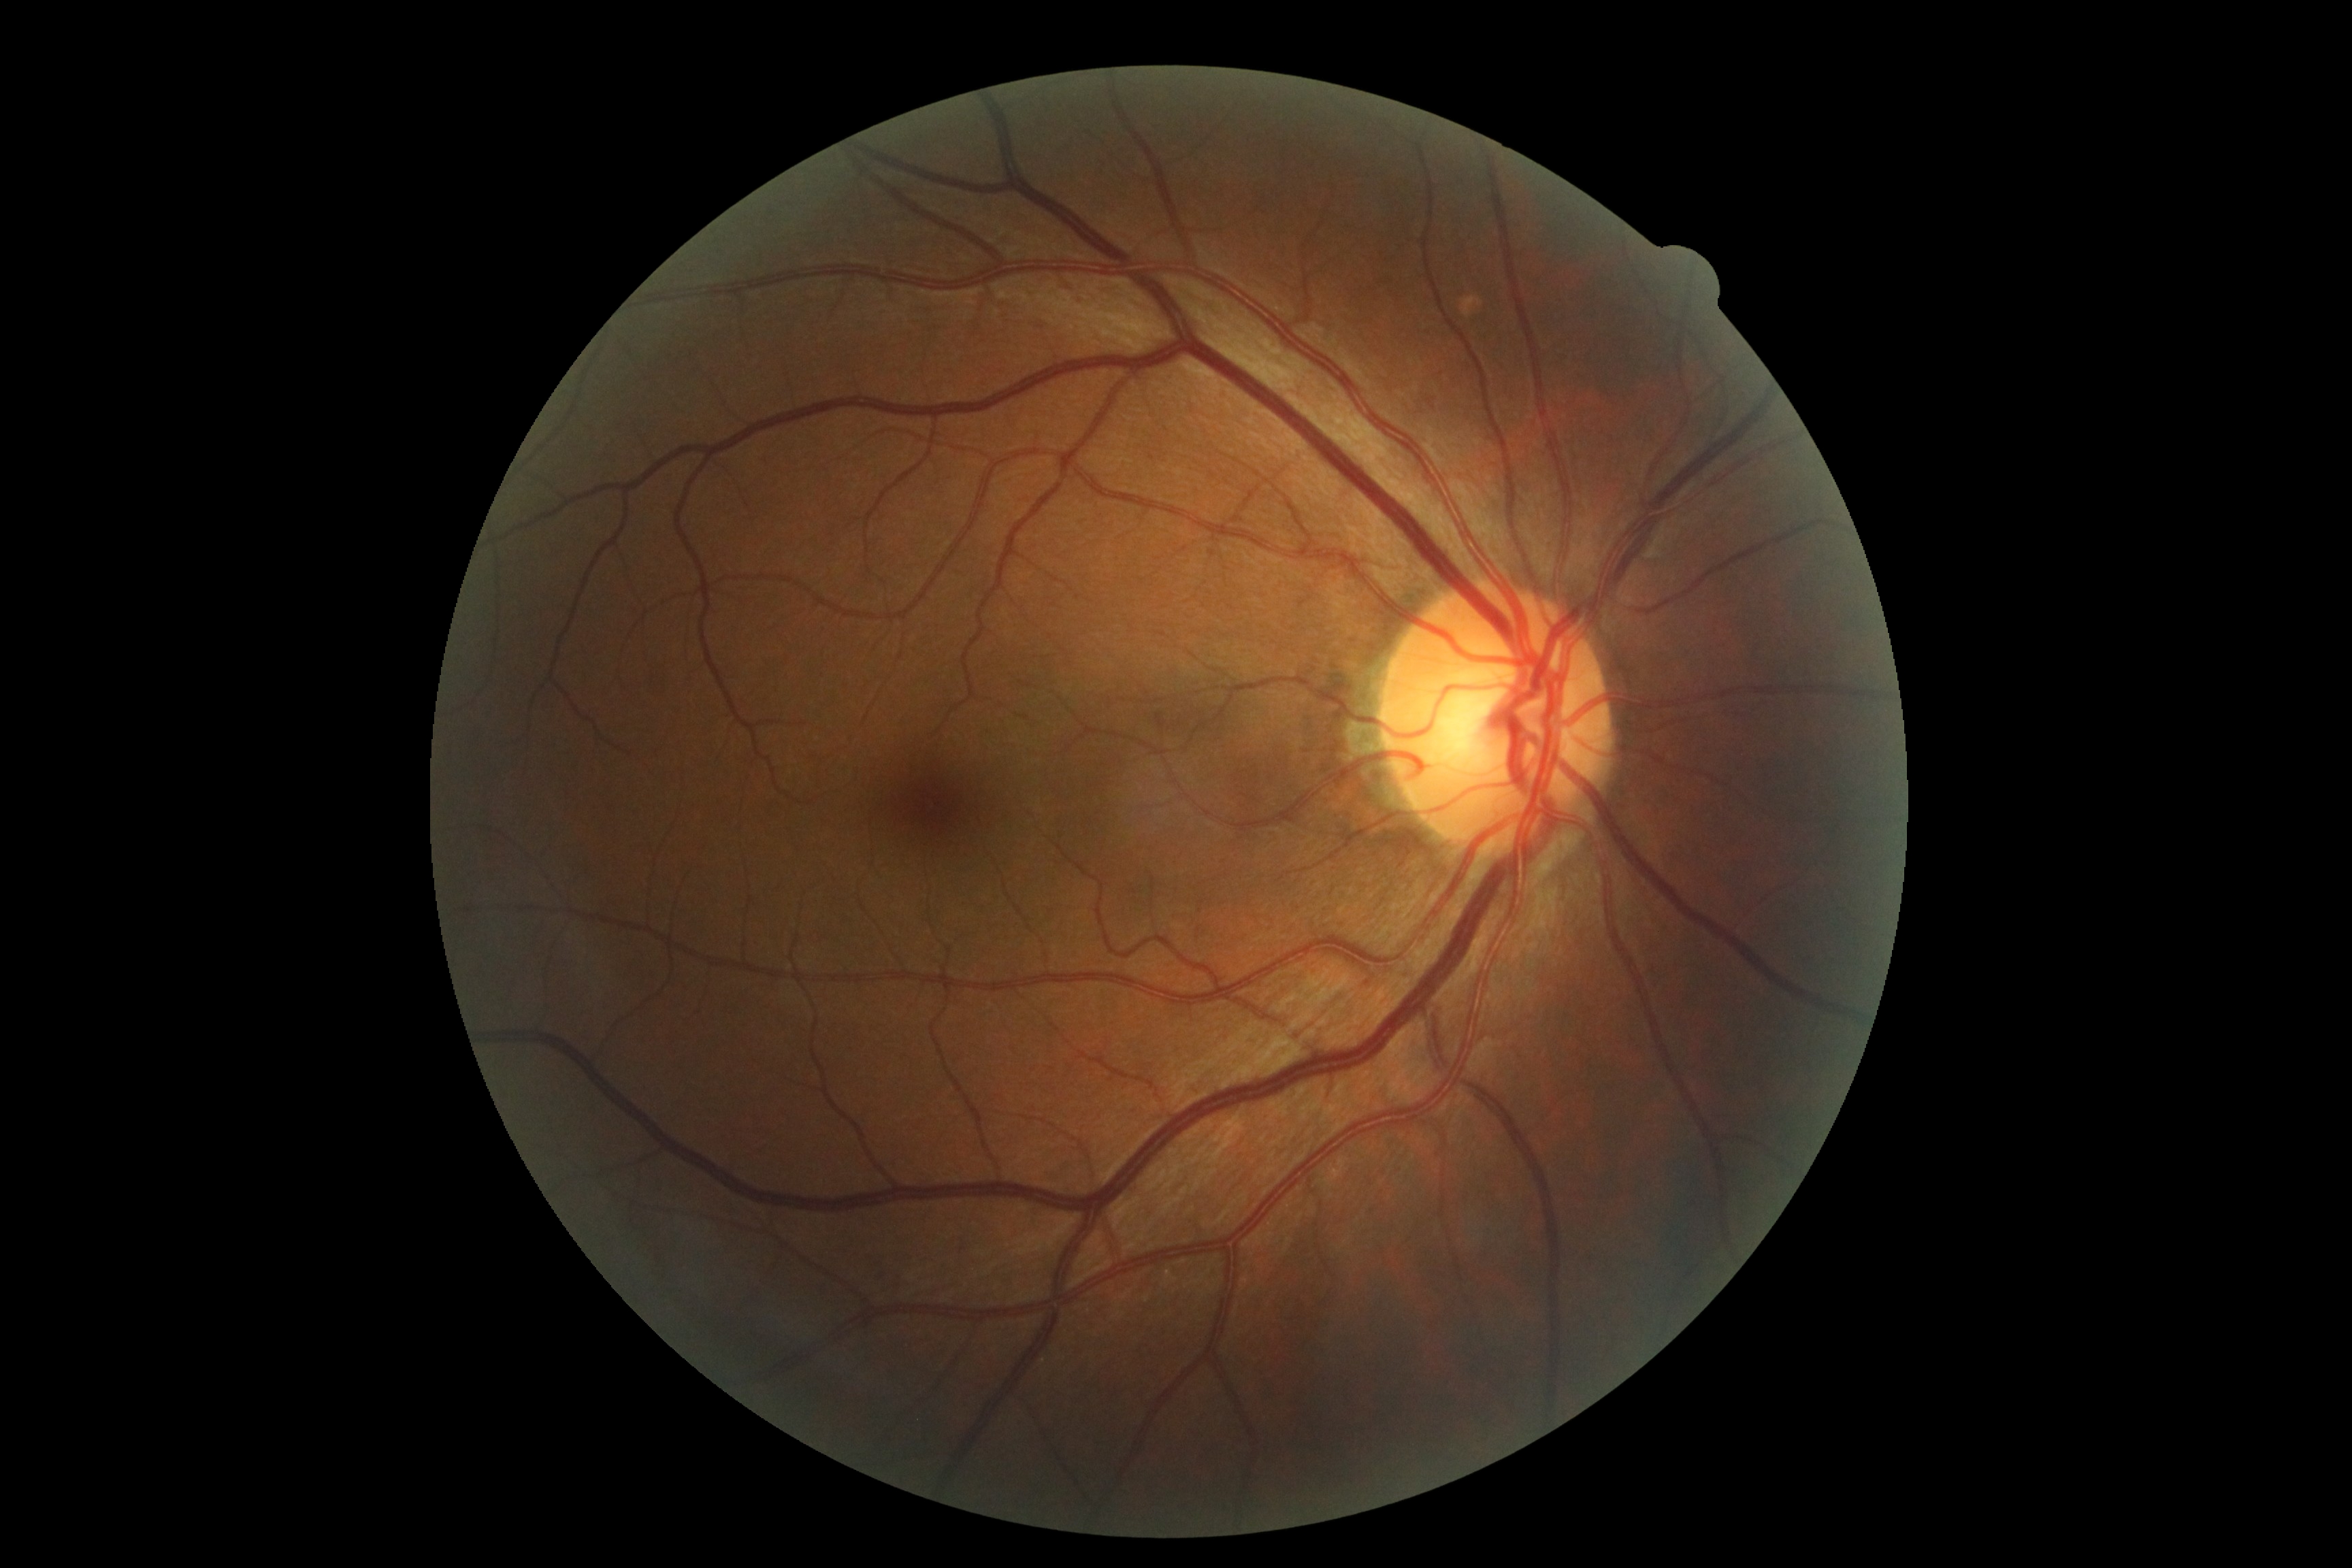   dr_grade: 0
  dr_impression: no apparent DR